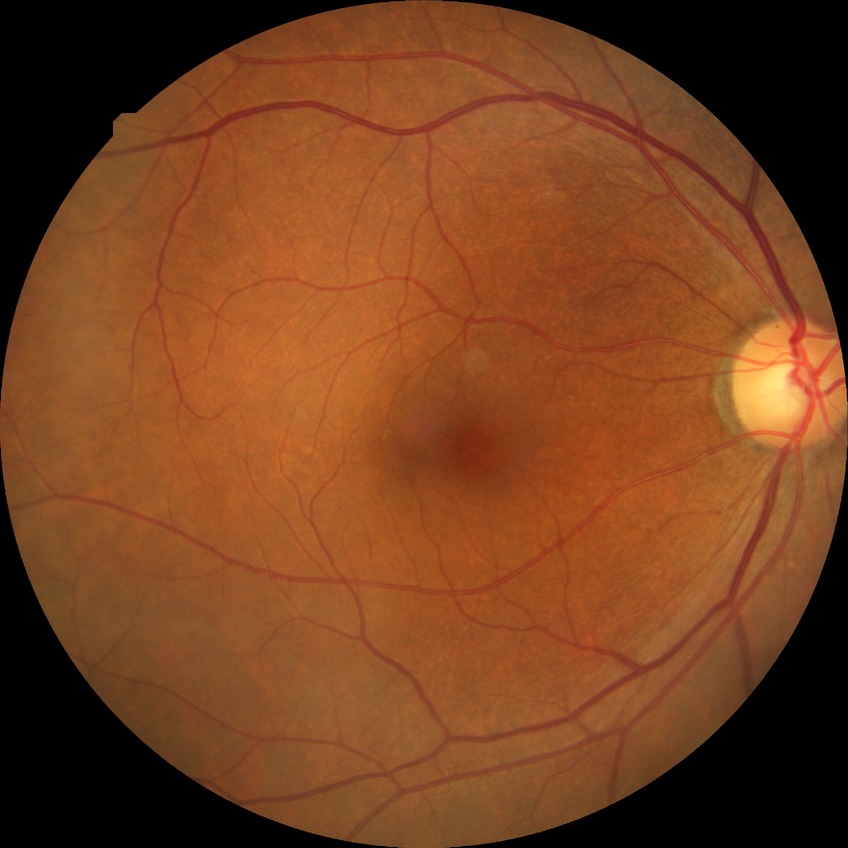
DR: NDR.